FOV: 45 degrees: 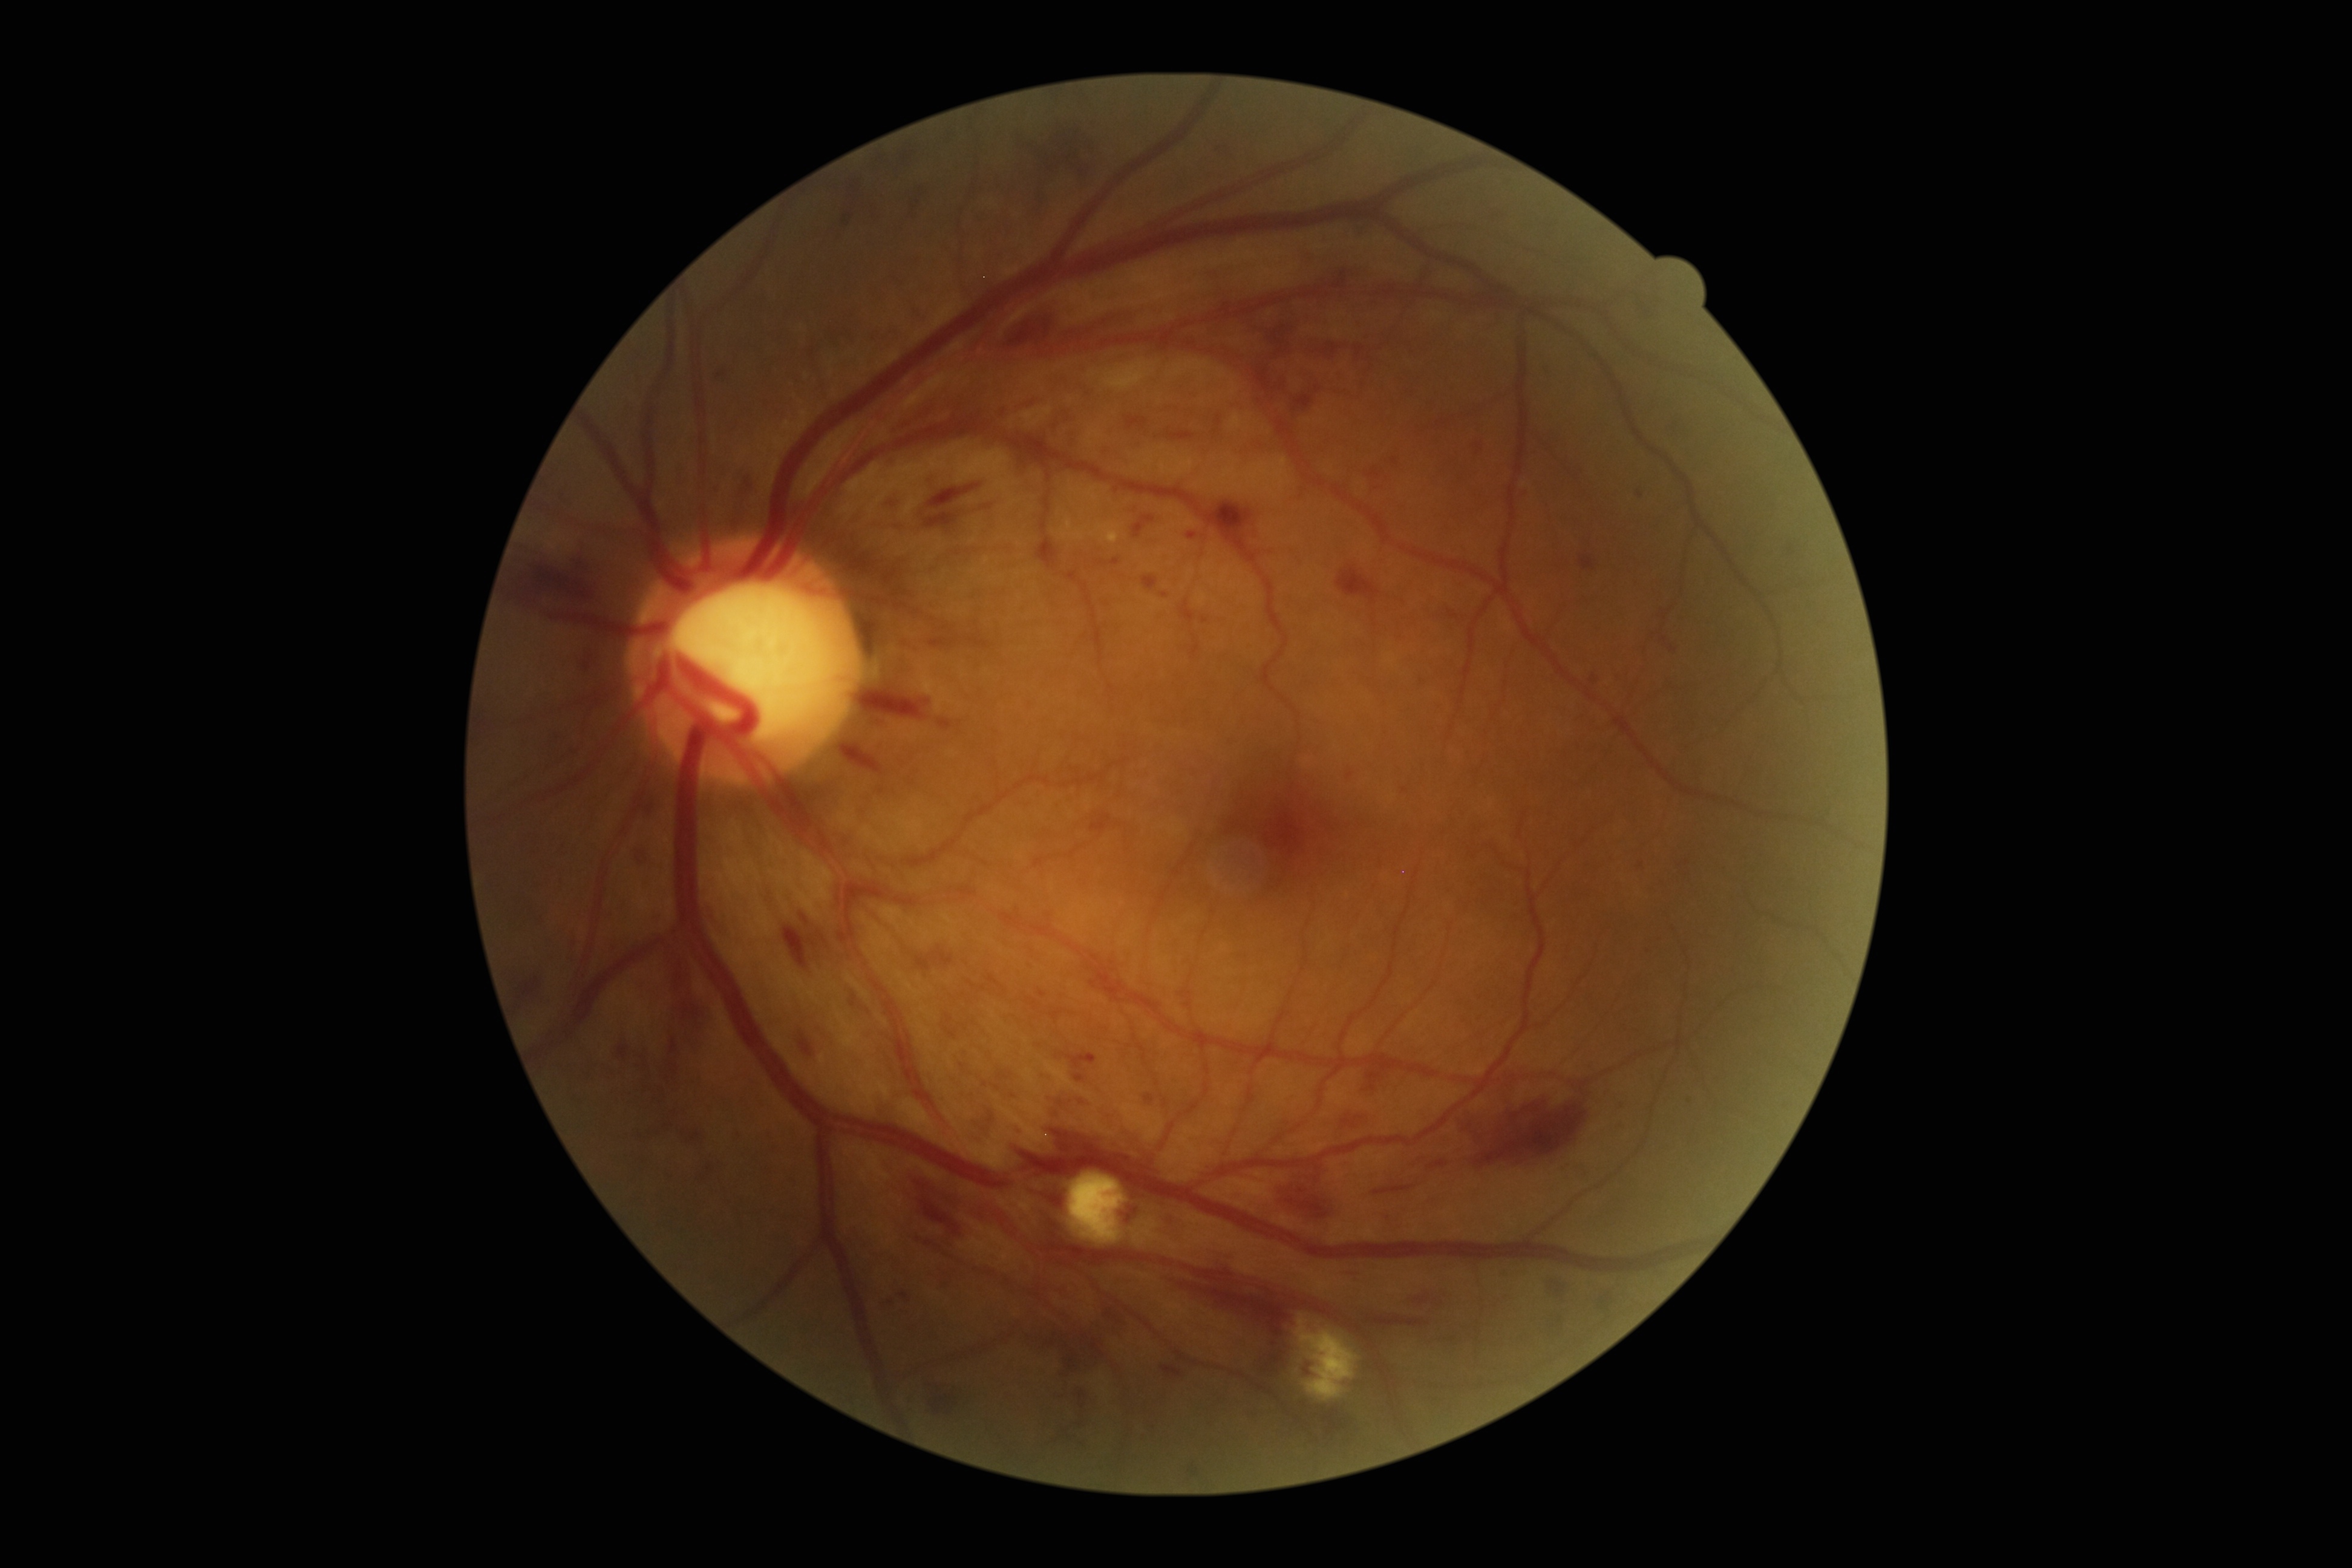
DR severity is 3.